CFP; 2352 x 1568 pixels; 45-degree field of view
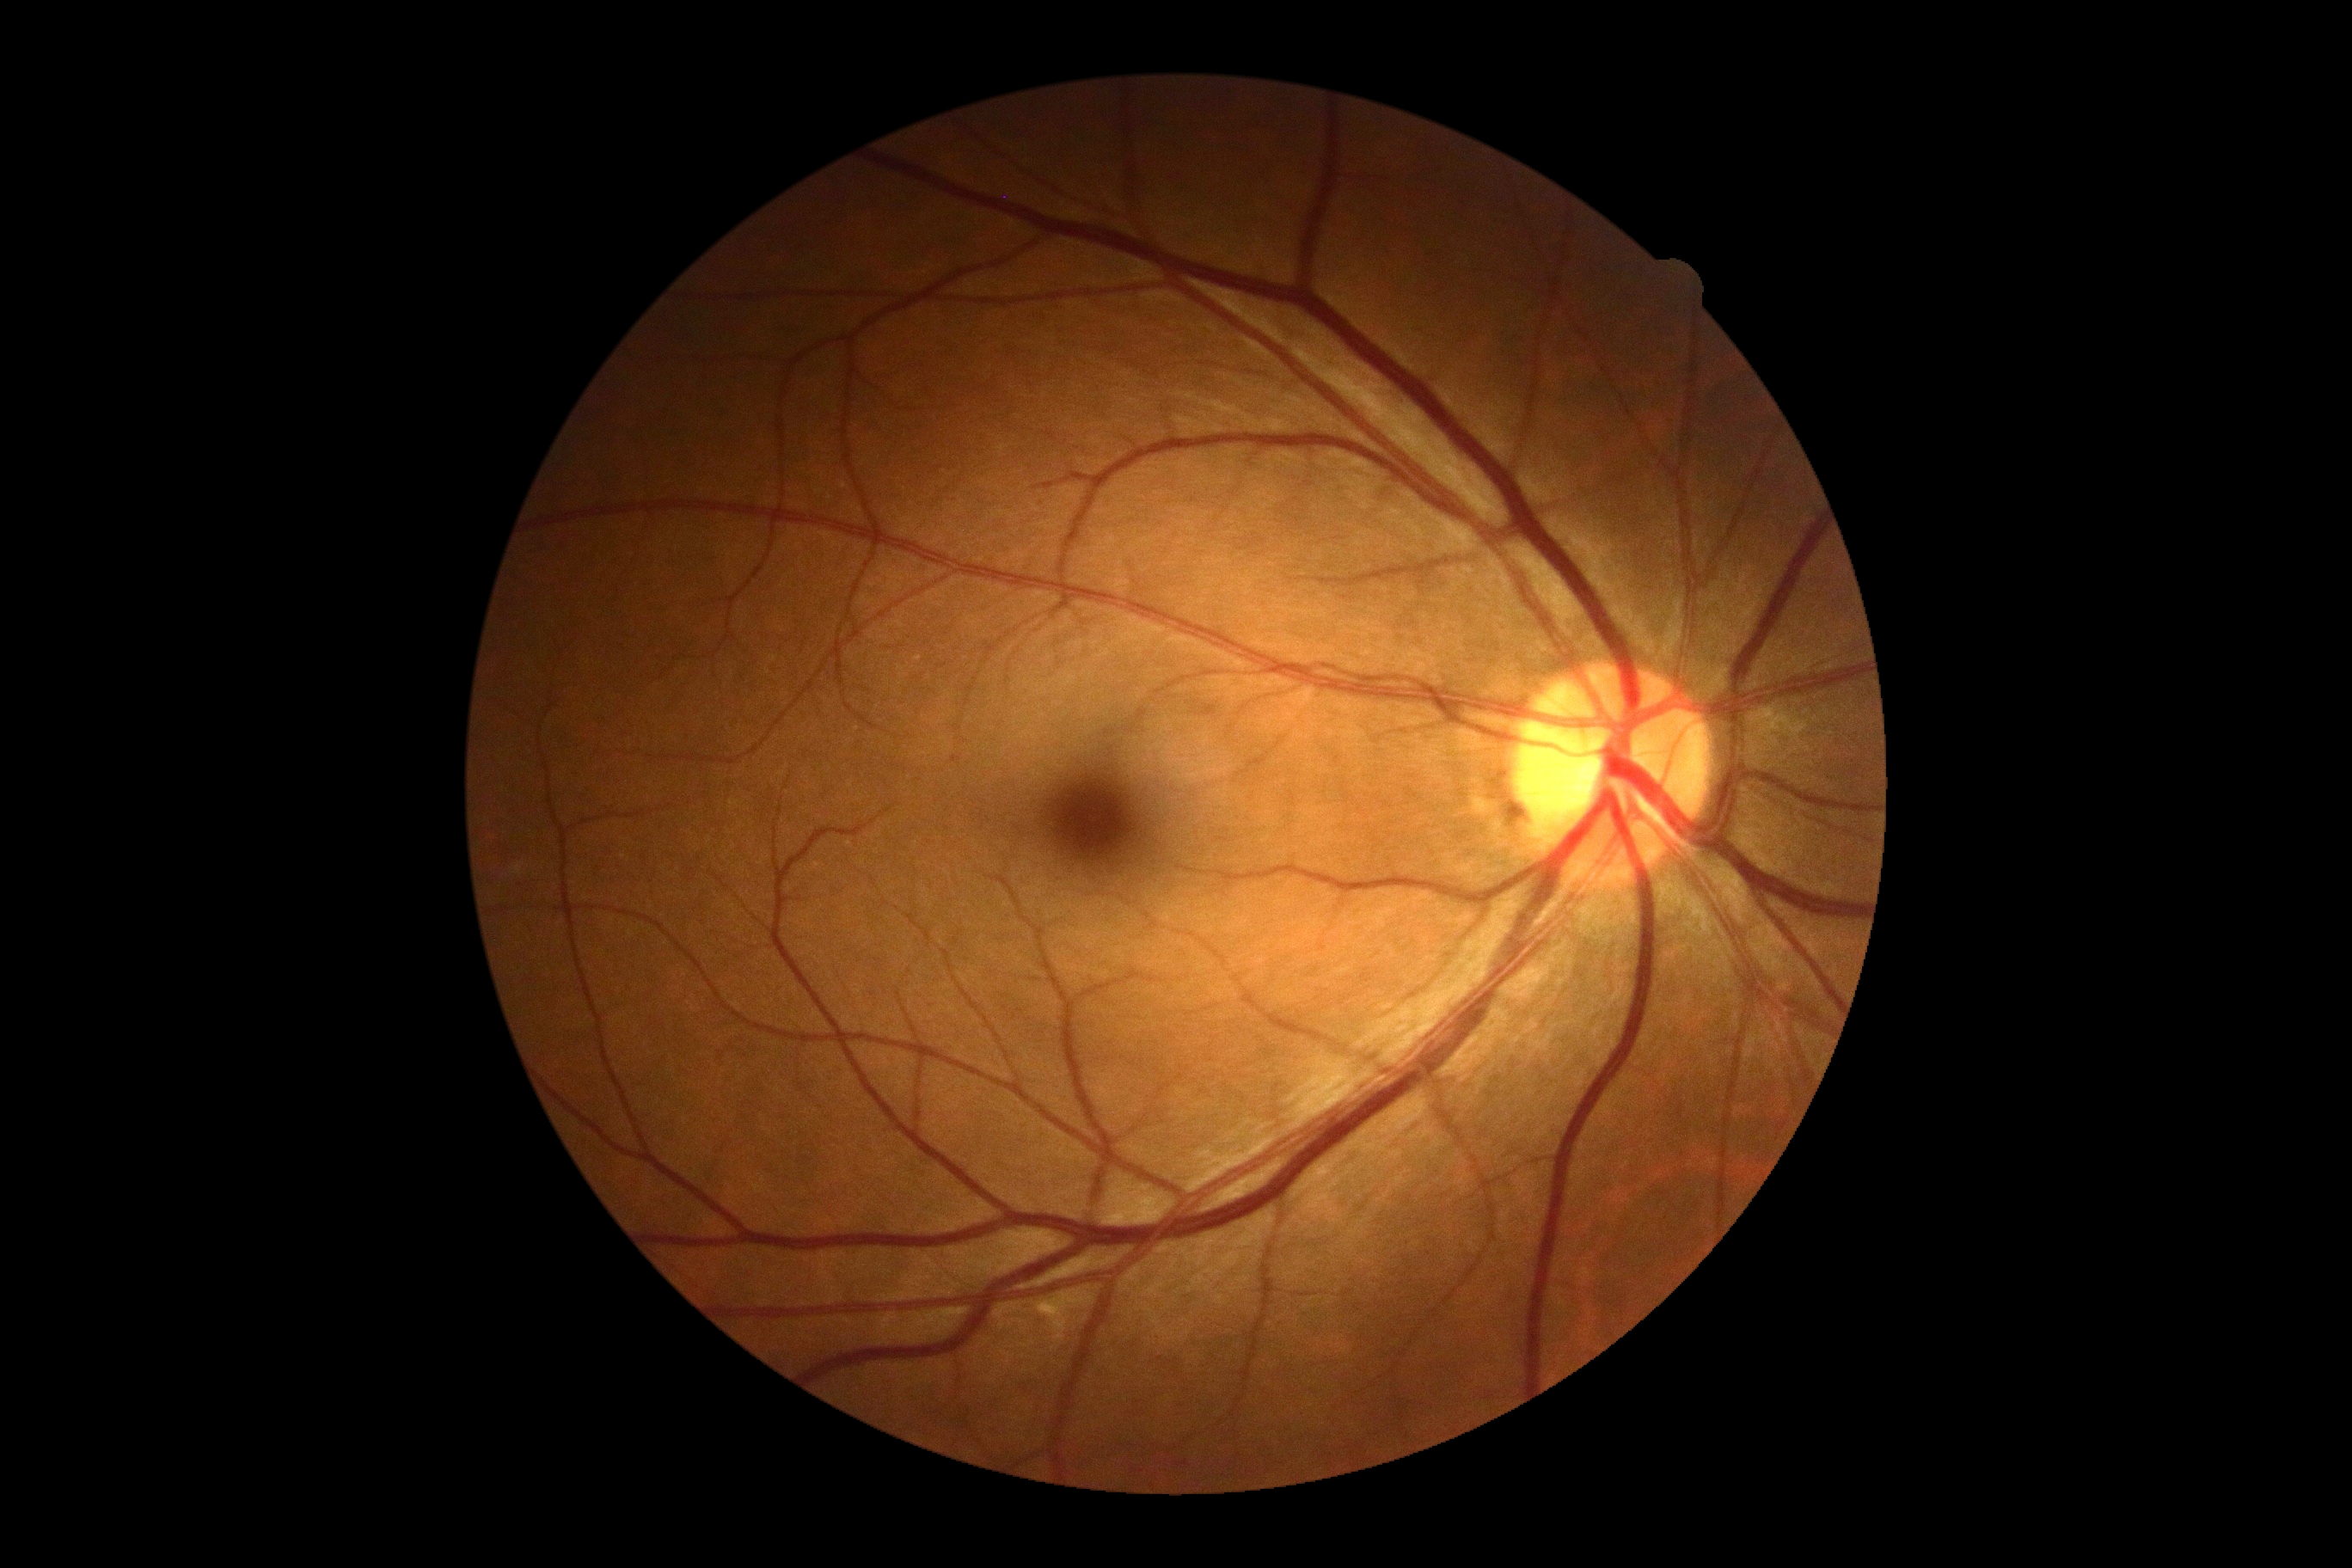
Diabetic retinopathy (DR): grade 0 (no apparent retinopathy).